Optic disc-centered crop from a color fundus photograph; captured on a Topcon TRC retinal camera — 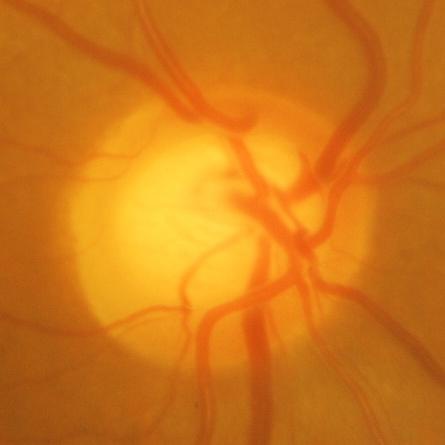 Glaucomatous optic neuropathy is present. Findings consistent with glaucomatous optic neuropathy.